Image size 2184x1682, color fundus photograph, 45° FOV: 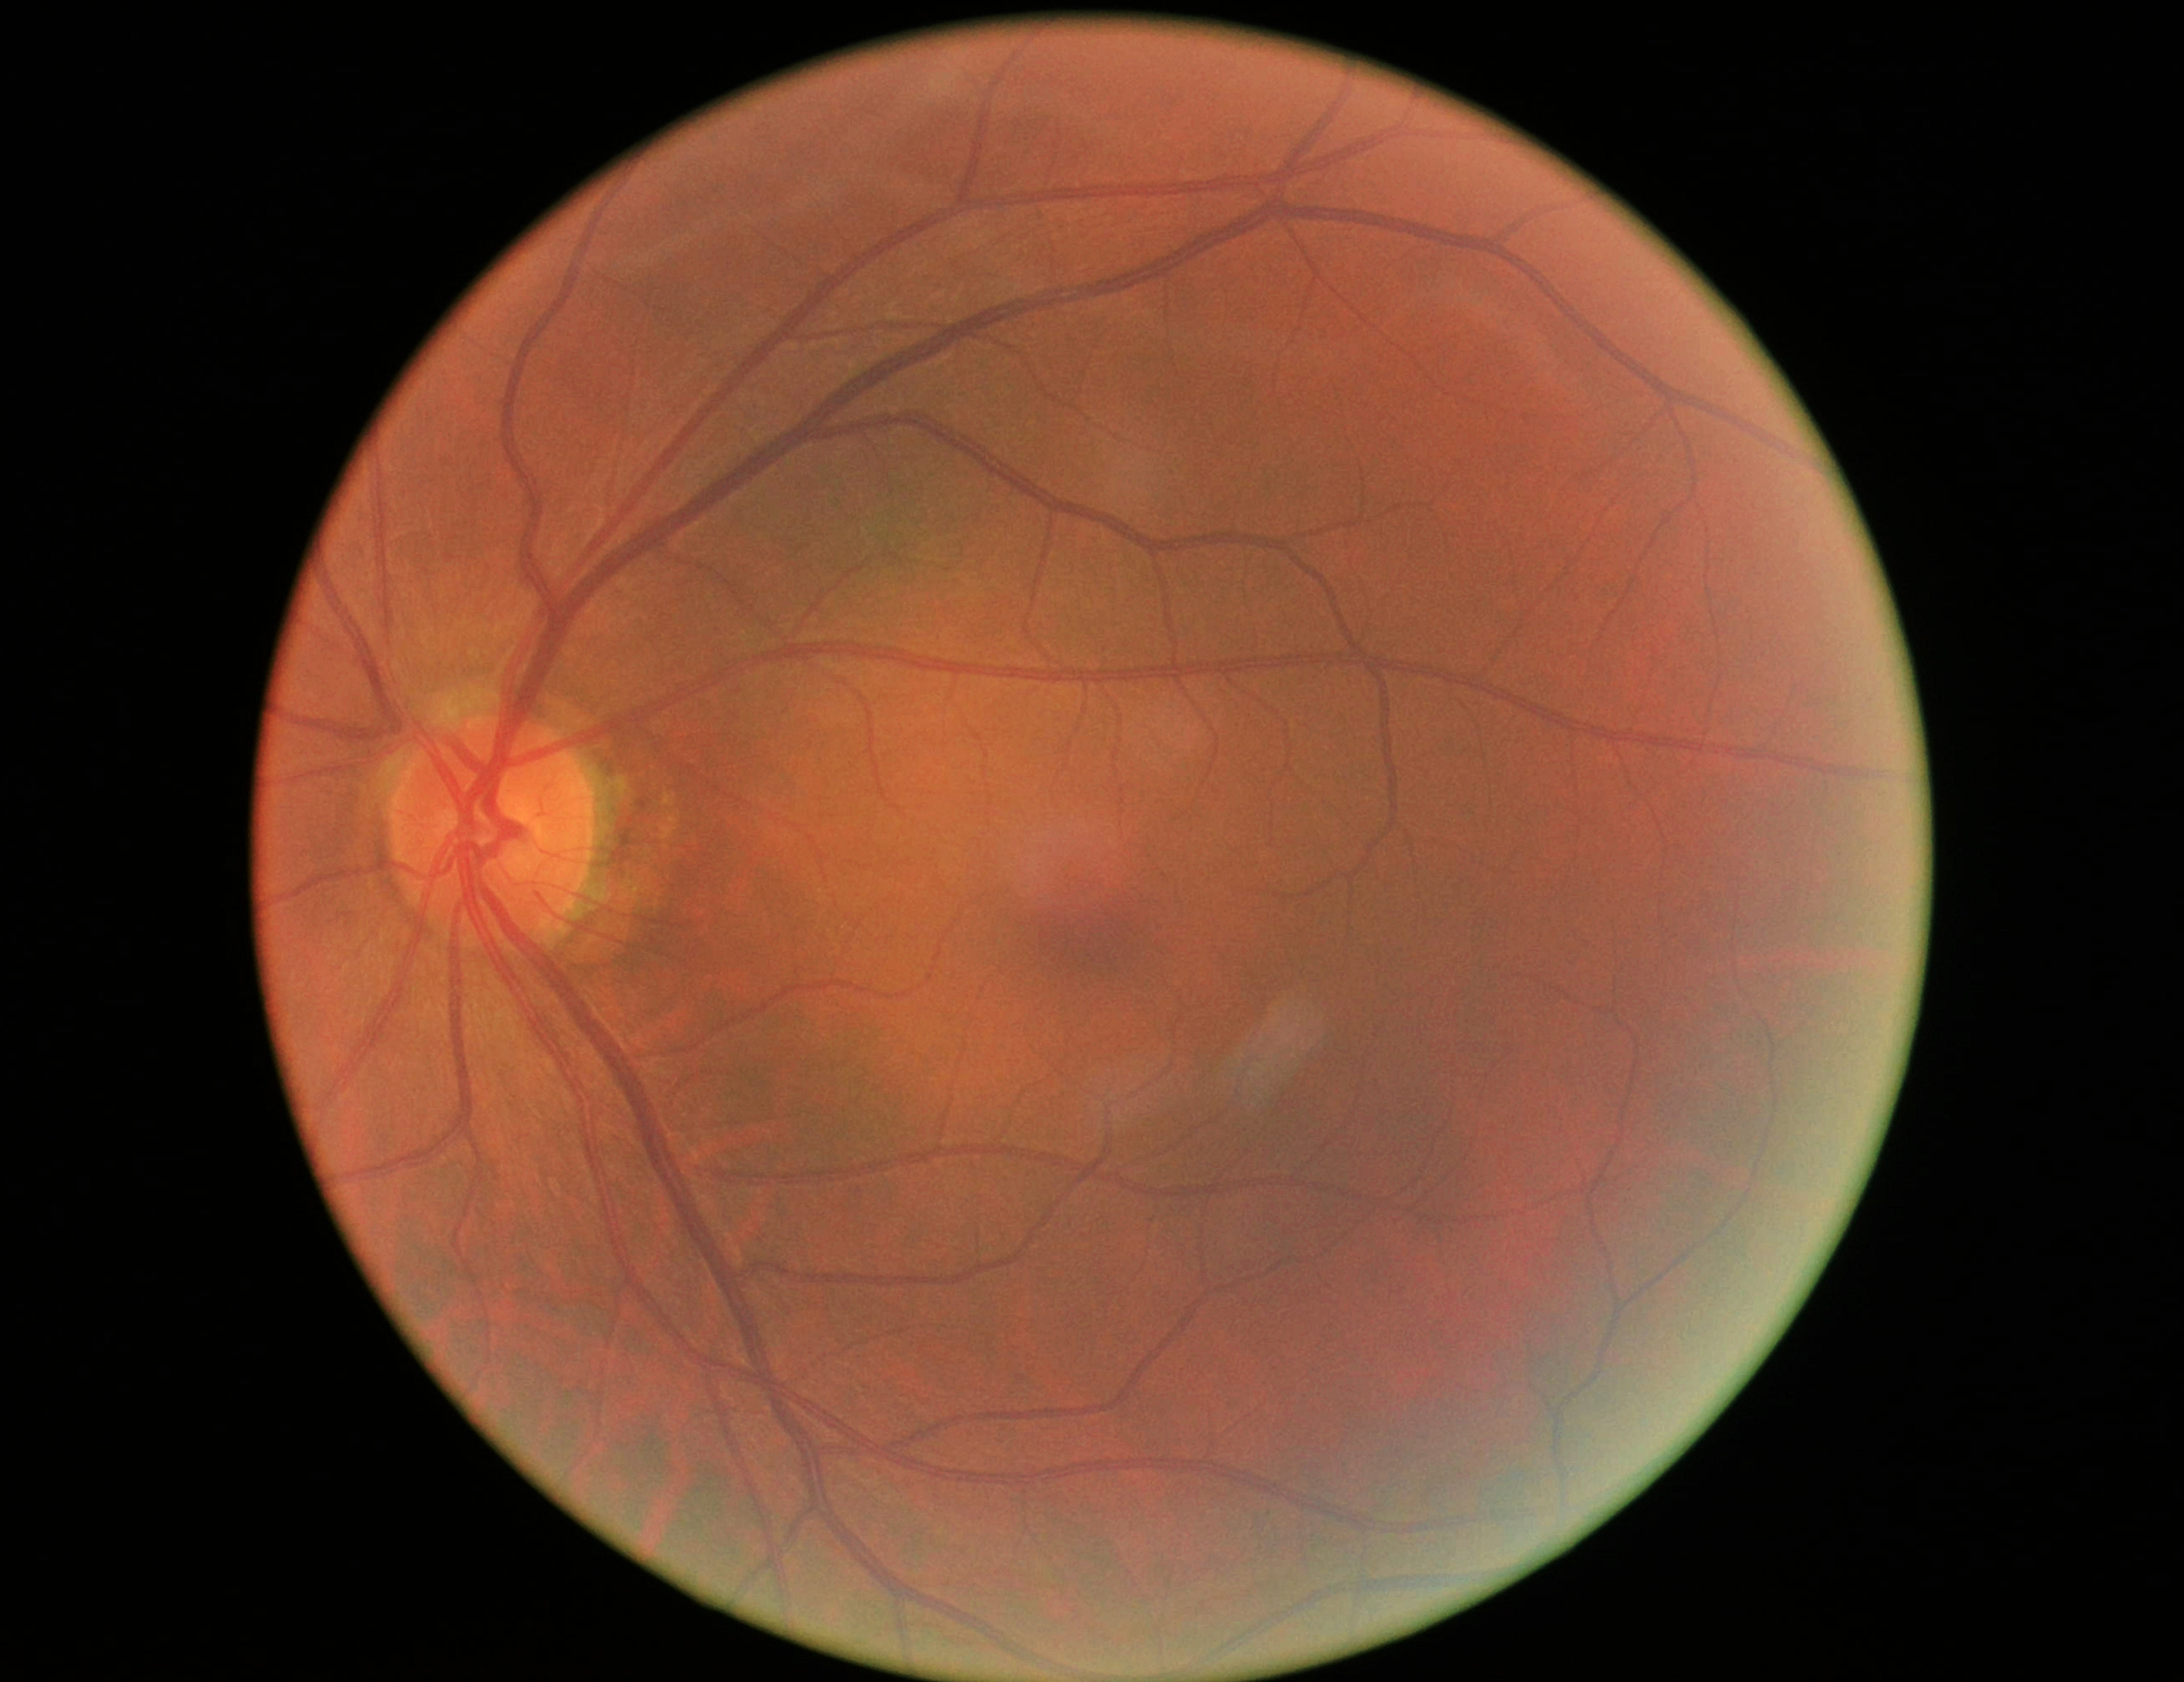
Diabetic retinopathy (DR): no apparent diabetic retinopathy (grade 0) — no visible signs of diabetic retinopathy. No apparent diabetic retinopathy.